FOV: 45 degrees · 2352x1568px
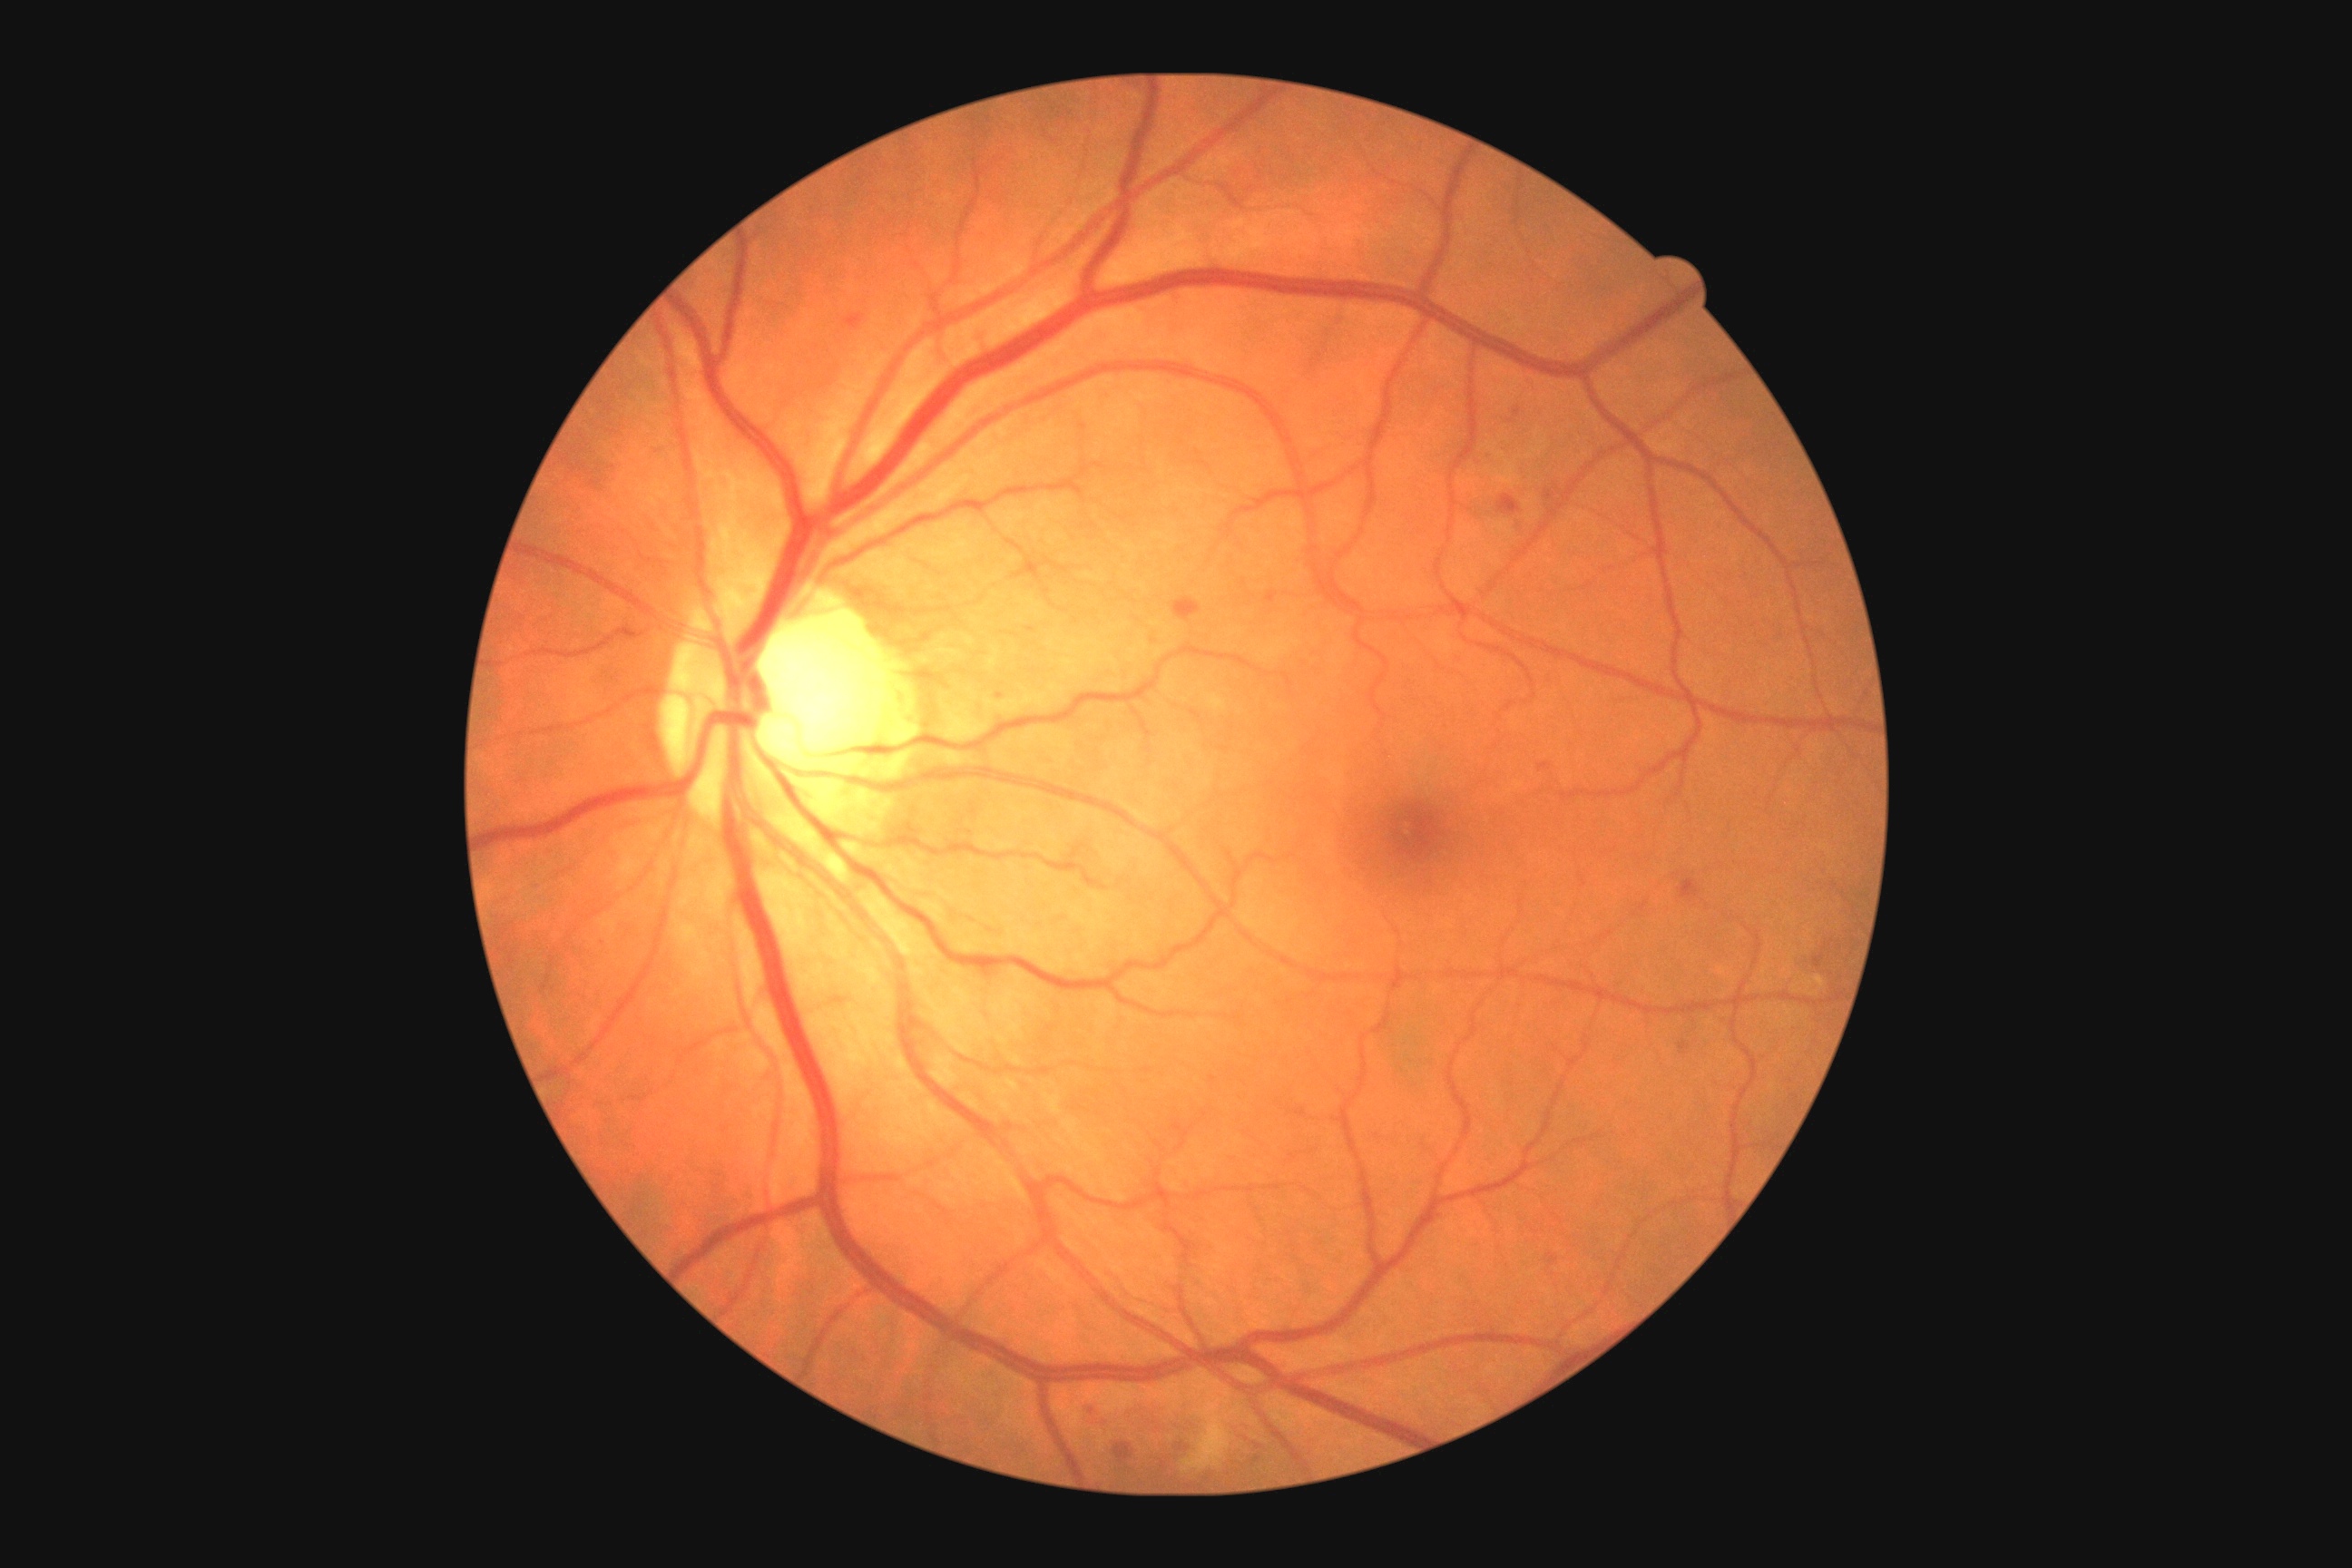
Retinopathy: moderate non-proliferative diabetic retinopathy (grade 2) — more than just microaneurysms but less than severe NPDR; non-proliferative diabetic retinopathy
microaneurysms: [1266,593,1279,603] | [1814,954,1825,968] | [1678,1041,1690,1055] | [1545,491,1556,500] | [1173,1446,1188,1453] | [1540,763,1551,772] | [1161,1460,1166,1469] | [1514,407,1522,418]
Smaller microaneurysms around 1259:1459 | 1000:696 | 1259:1447
hard exudates: not present
hemorrhages: [1678,879,1701,899] | [1173,598,1202,622] | [845,313,865,329] | [1498,495,1522,516] | [1115,1442,1135,1464]
soft exudates: [1188,1427,1231,1471]